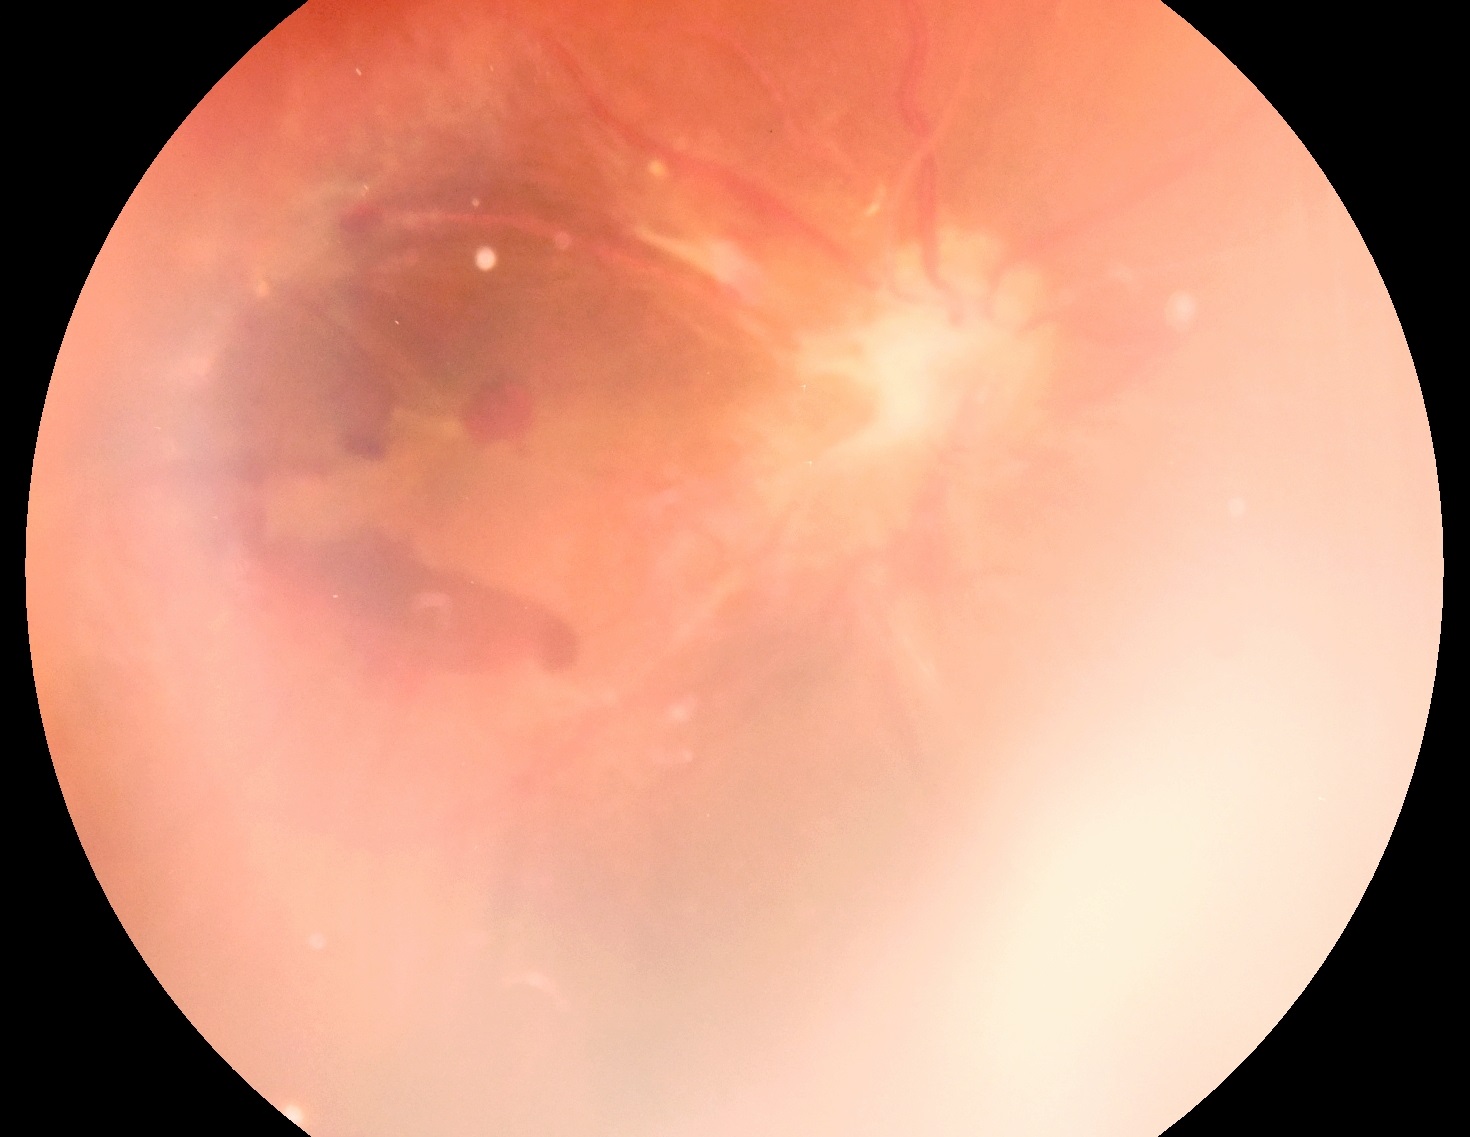

Diabetic retinopathy grade is PDR (4).